Modified Davis grading · acquired with a NIDEK AFC-230 · 45-degree field of view · without pupil dilation: 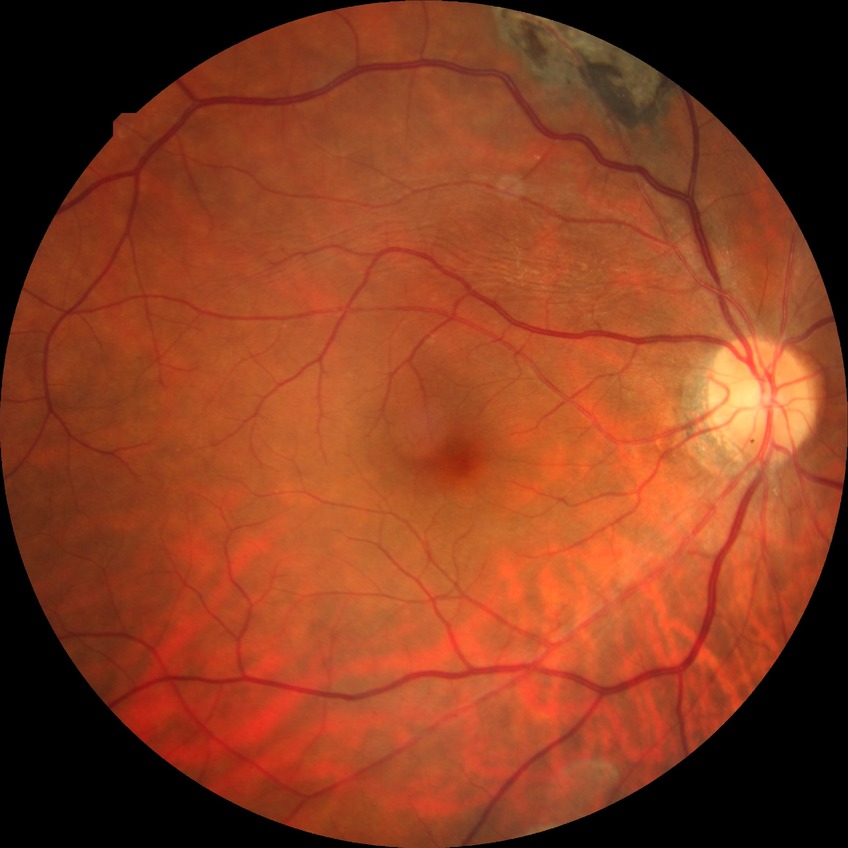
diabetic retinopathy (DR): NDR (no diabetic retinopathy).